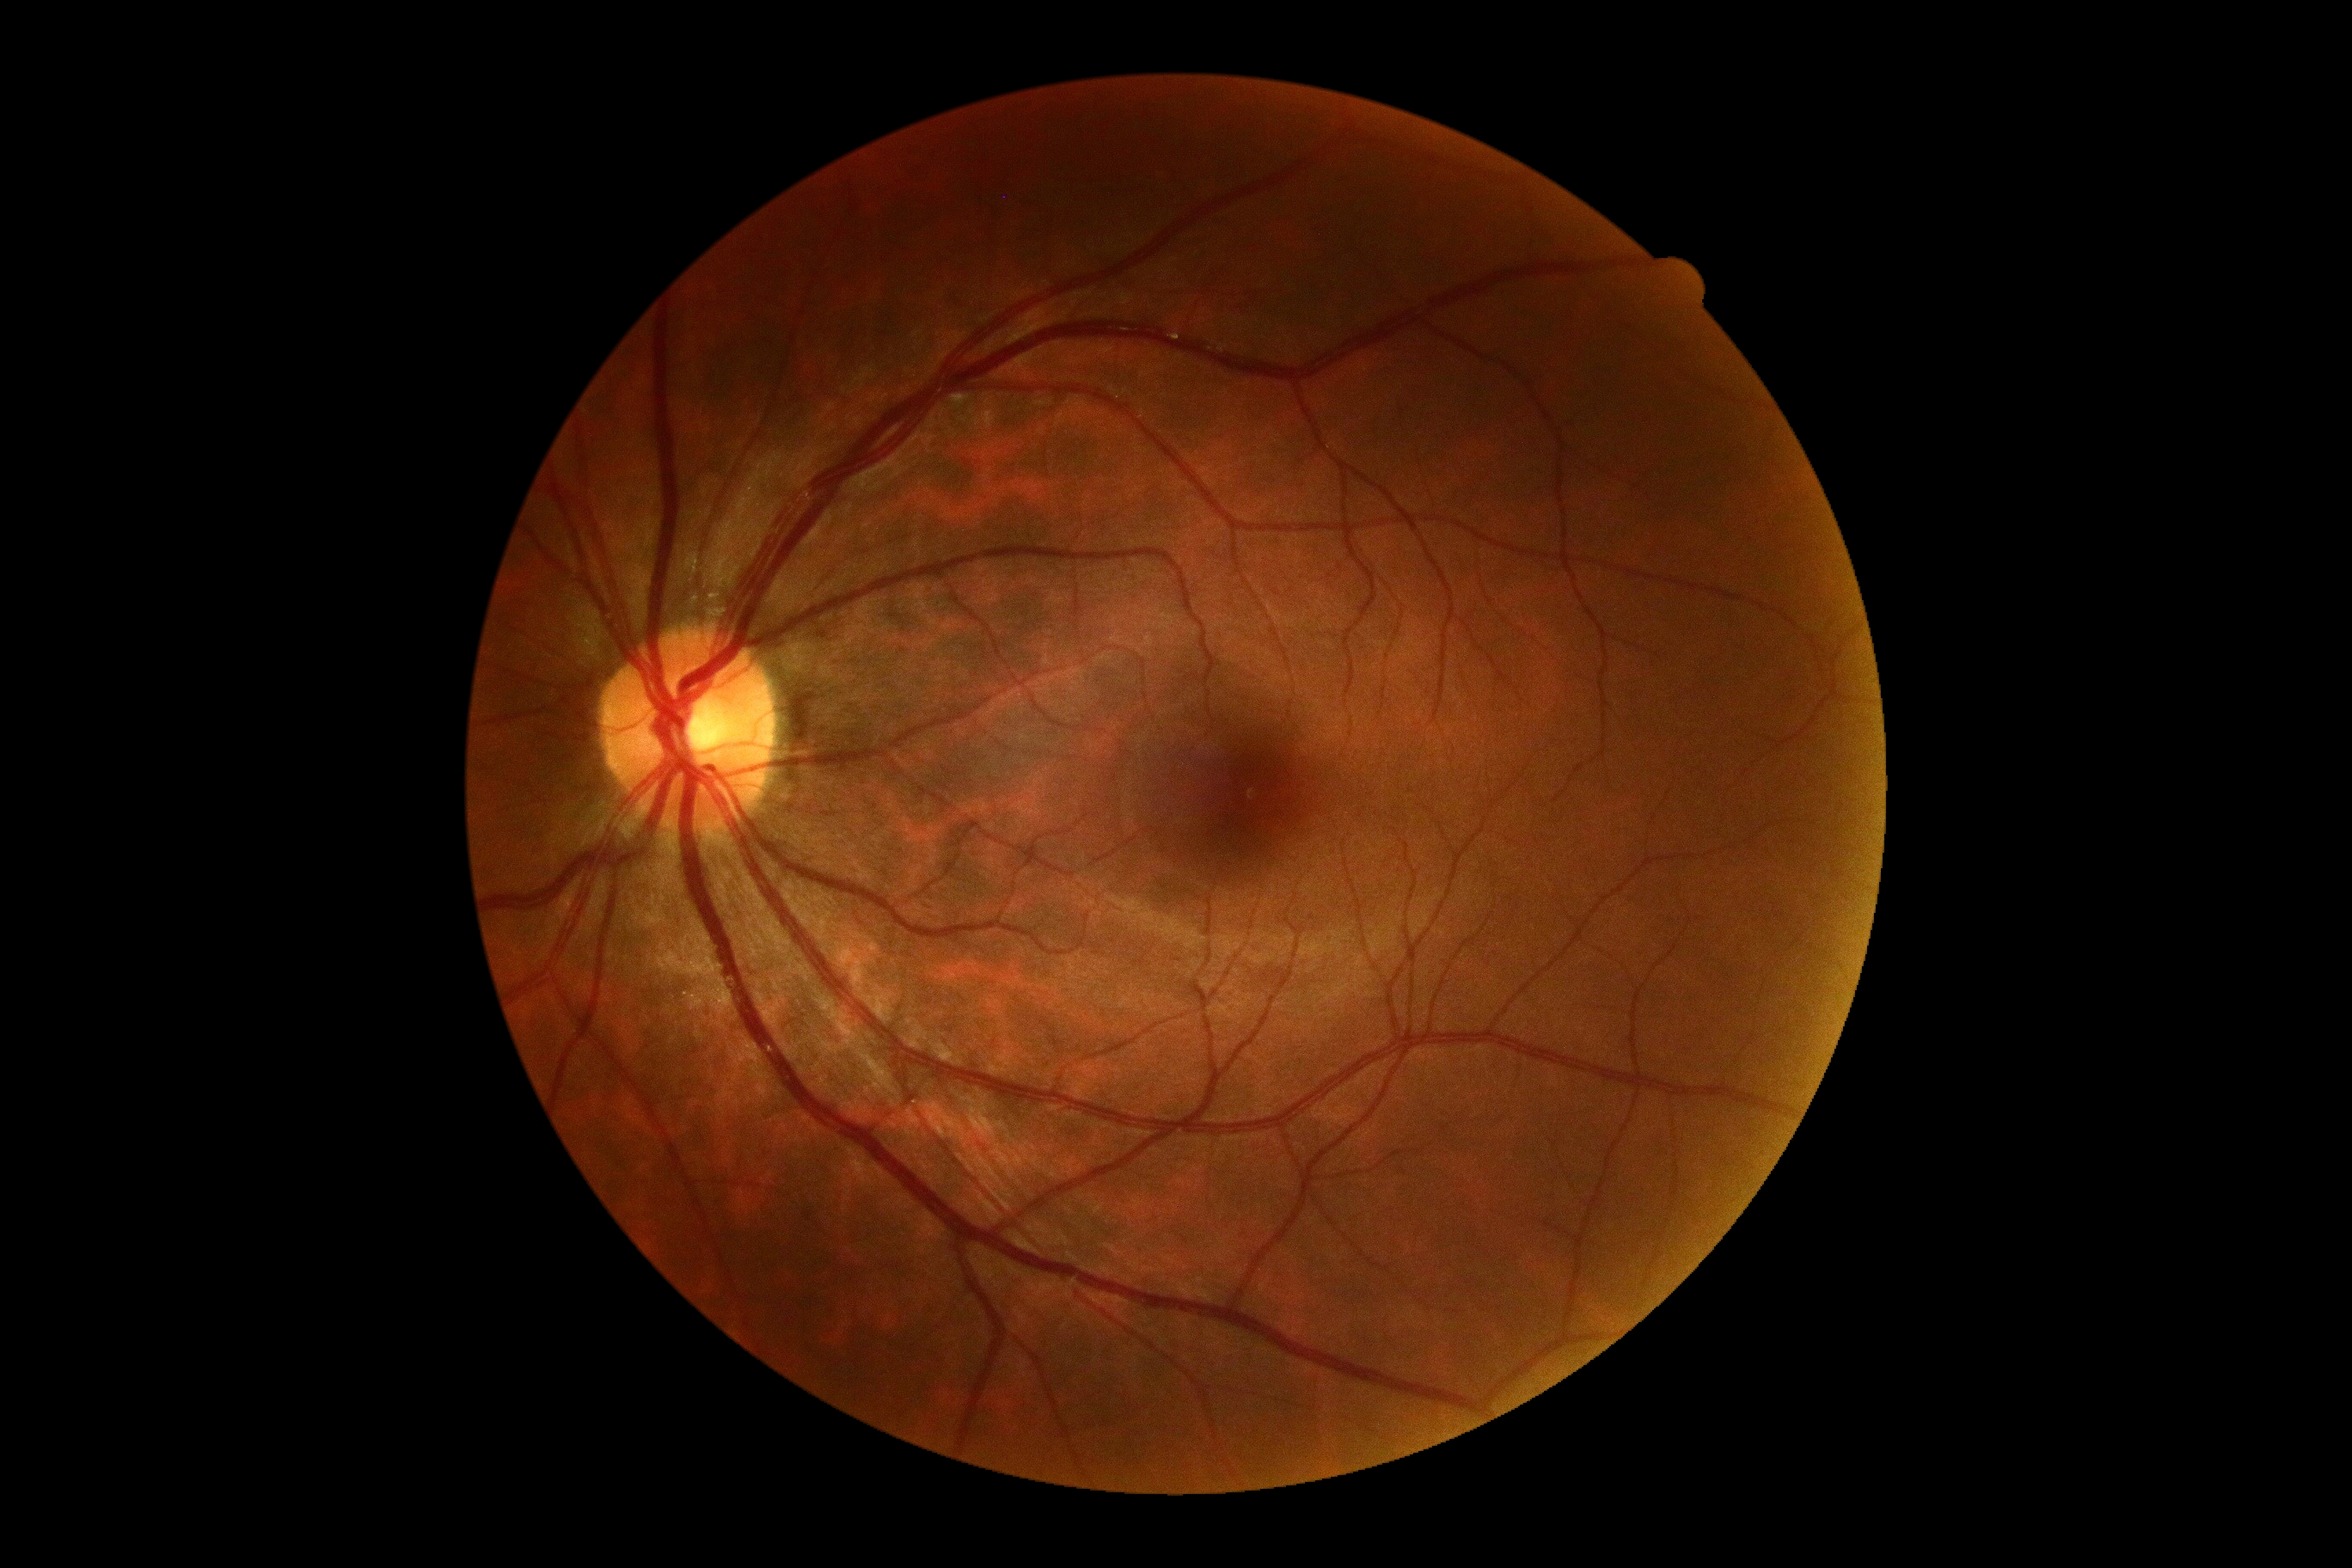

Diabetic retinopathy (DR) is grade 0 (no apparent retinopathy).
No DR findings.